45-degree field of view. CFP — 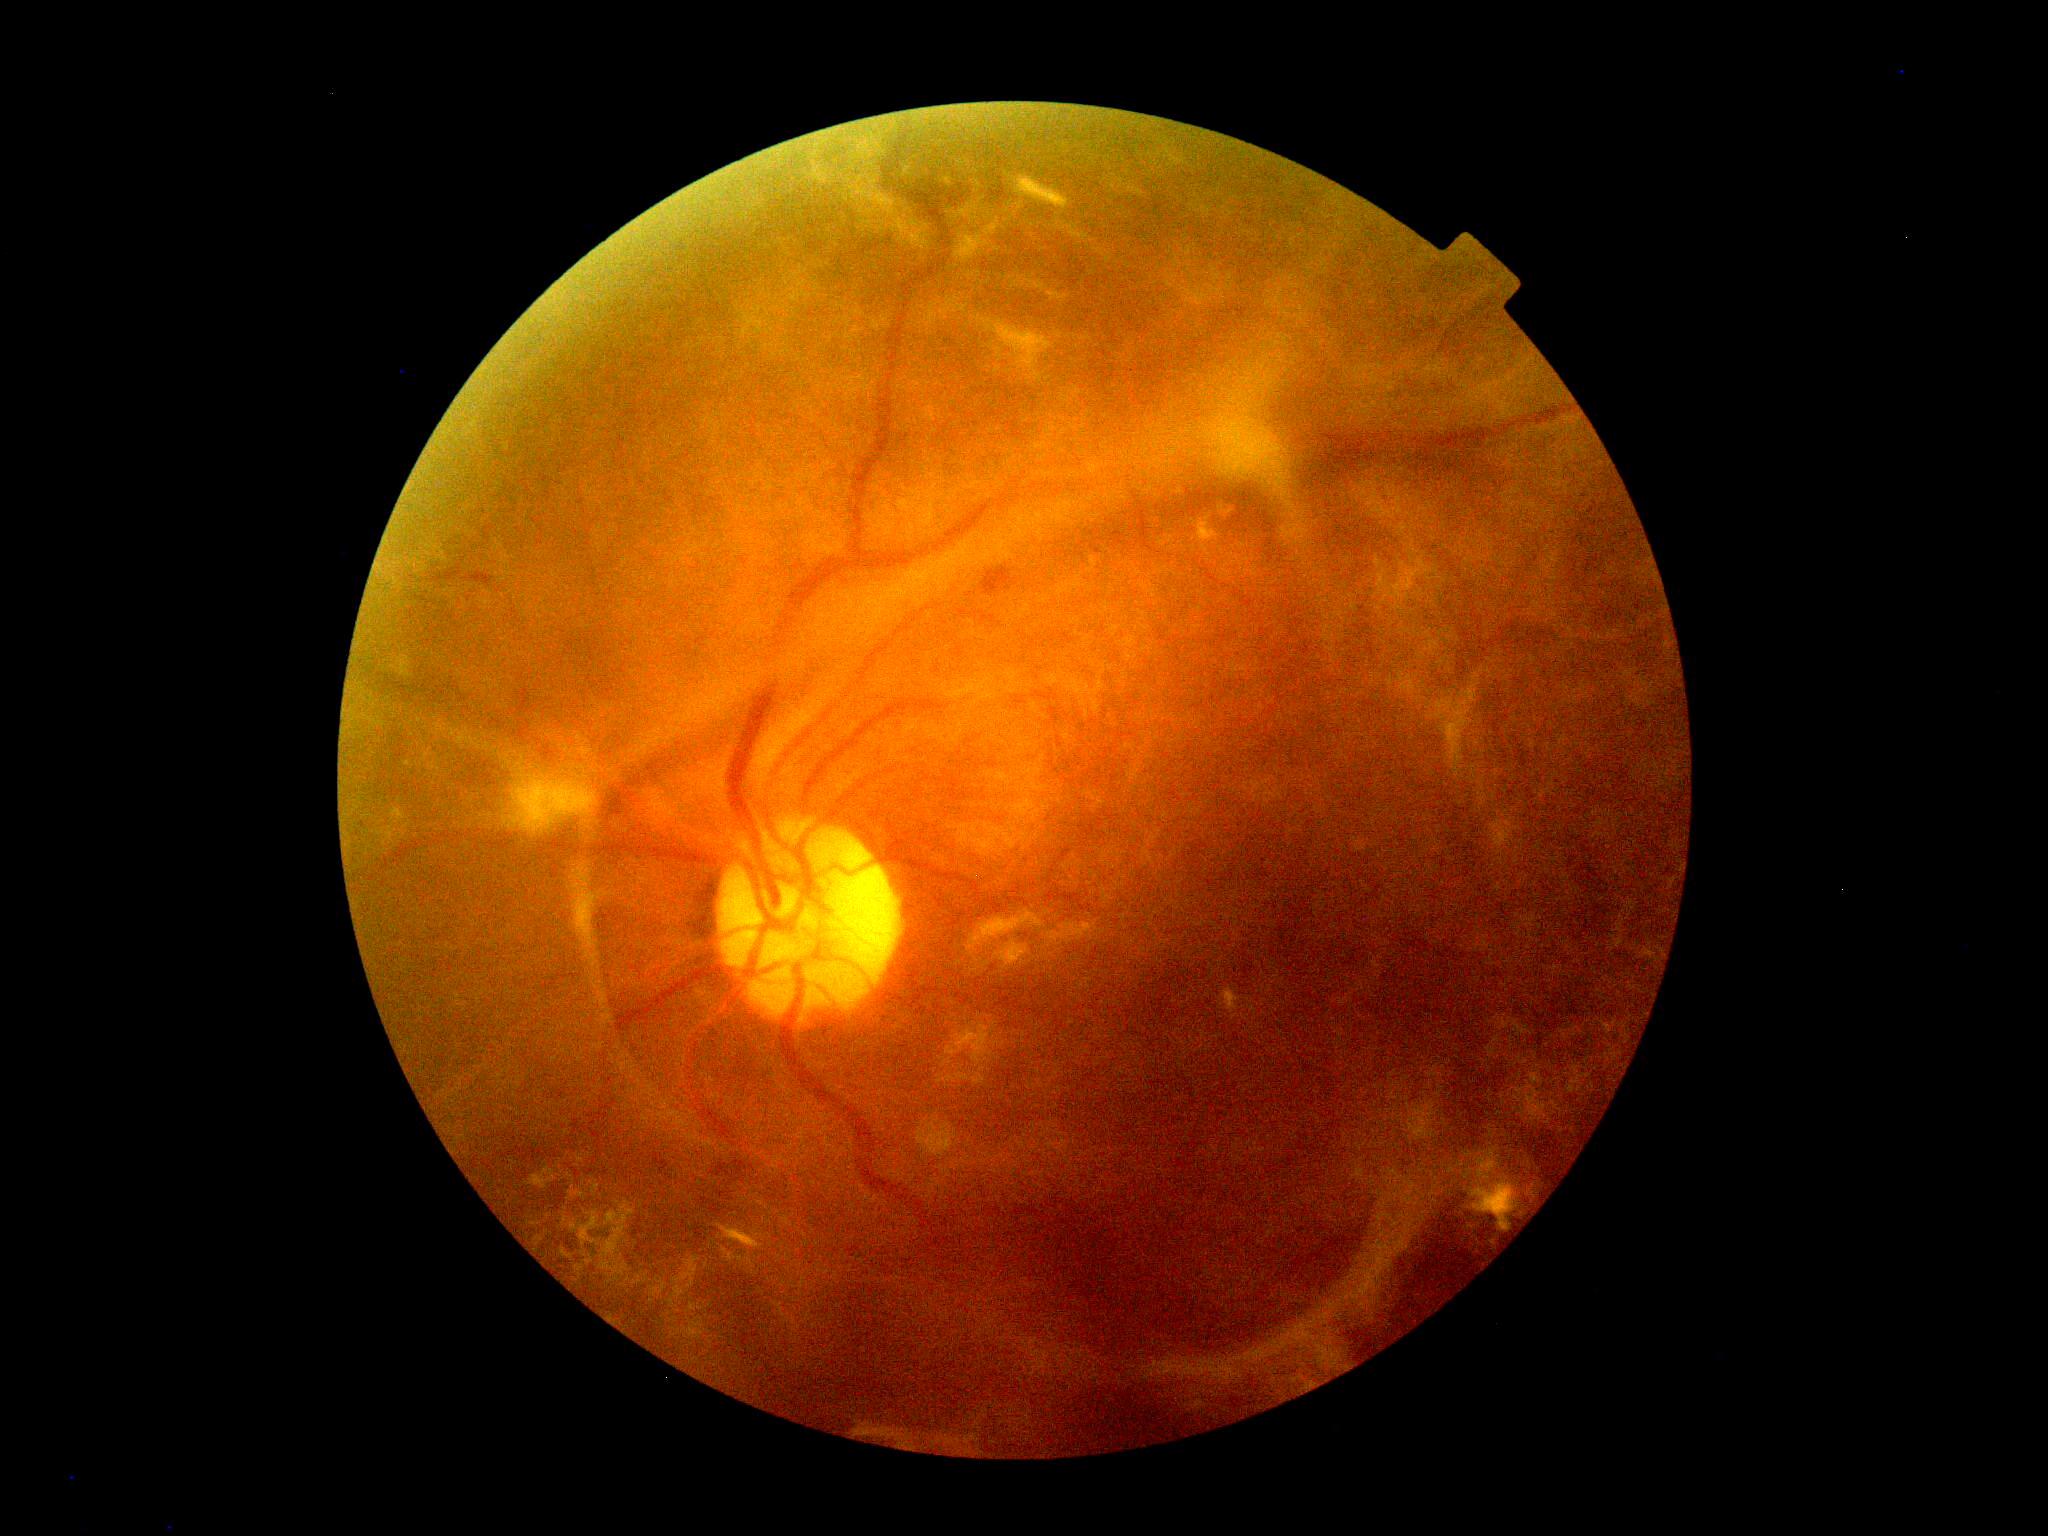
diabetic retinopathy severity = grade 4.